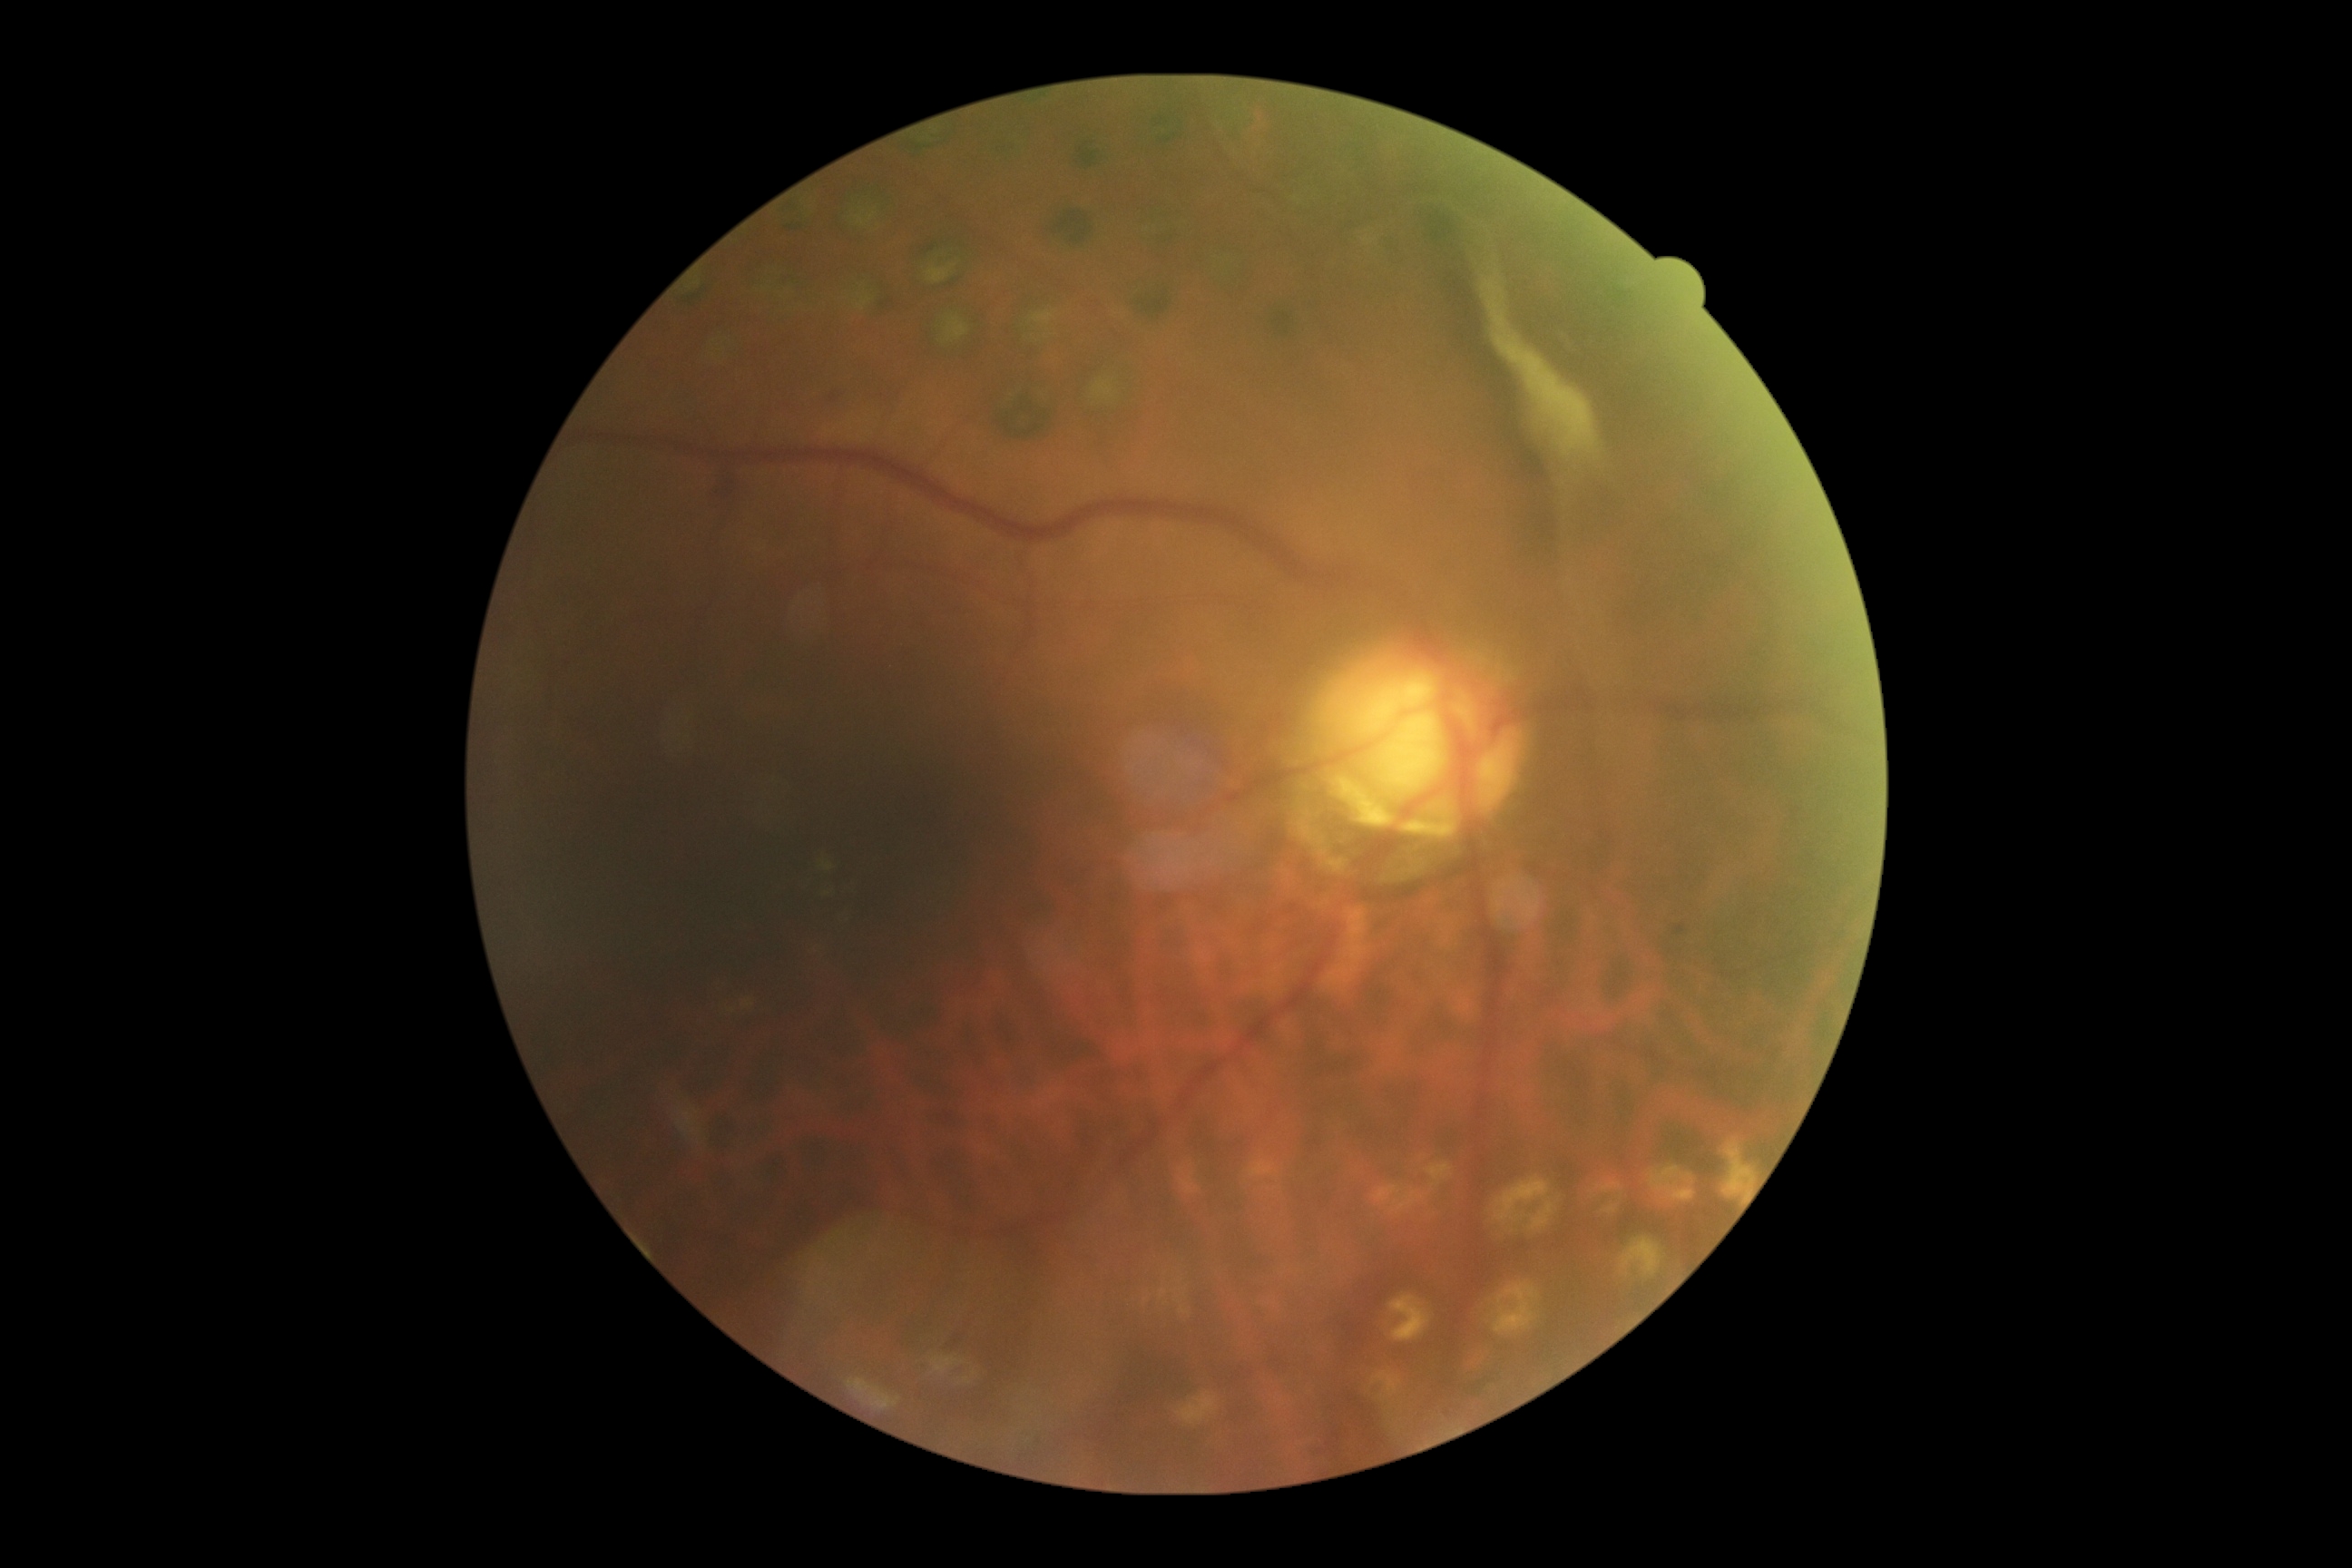

DR severity = 4